2352 by 1568 pixels:
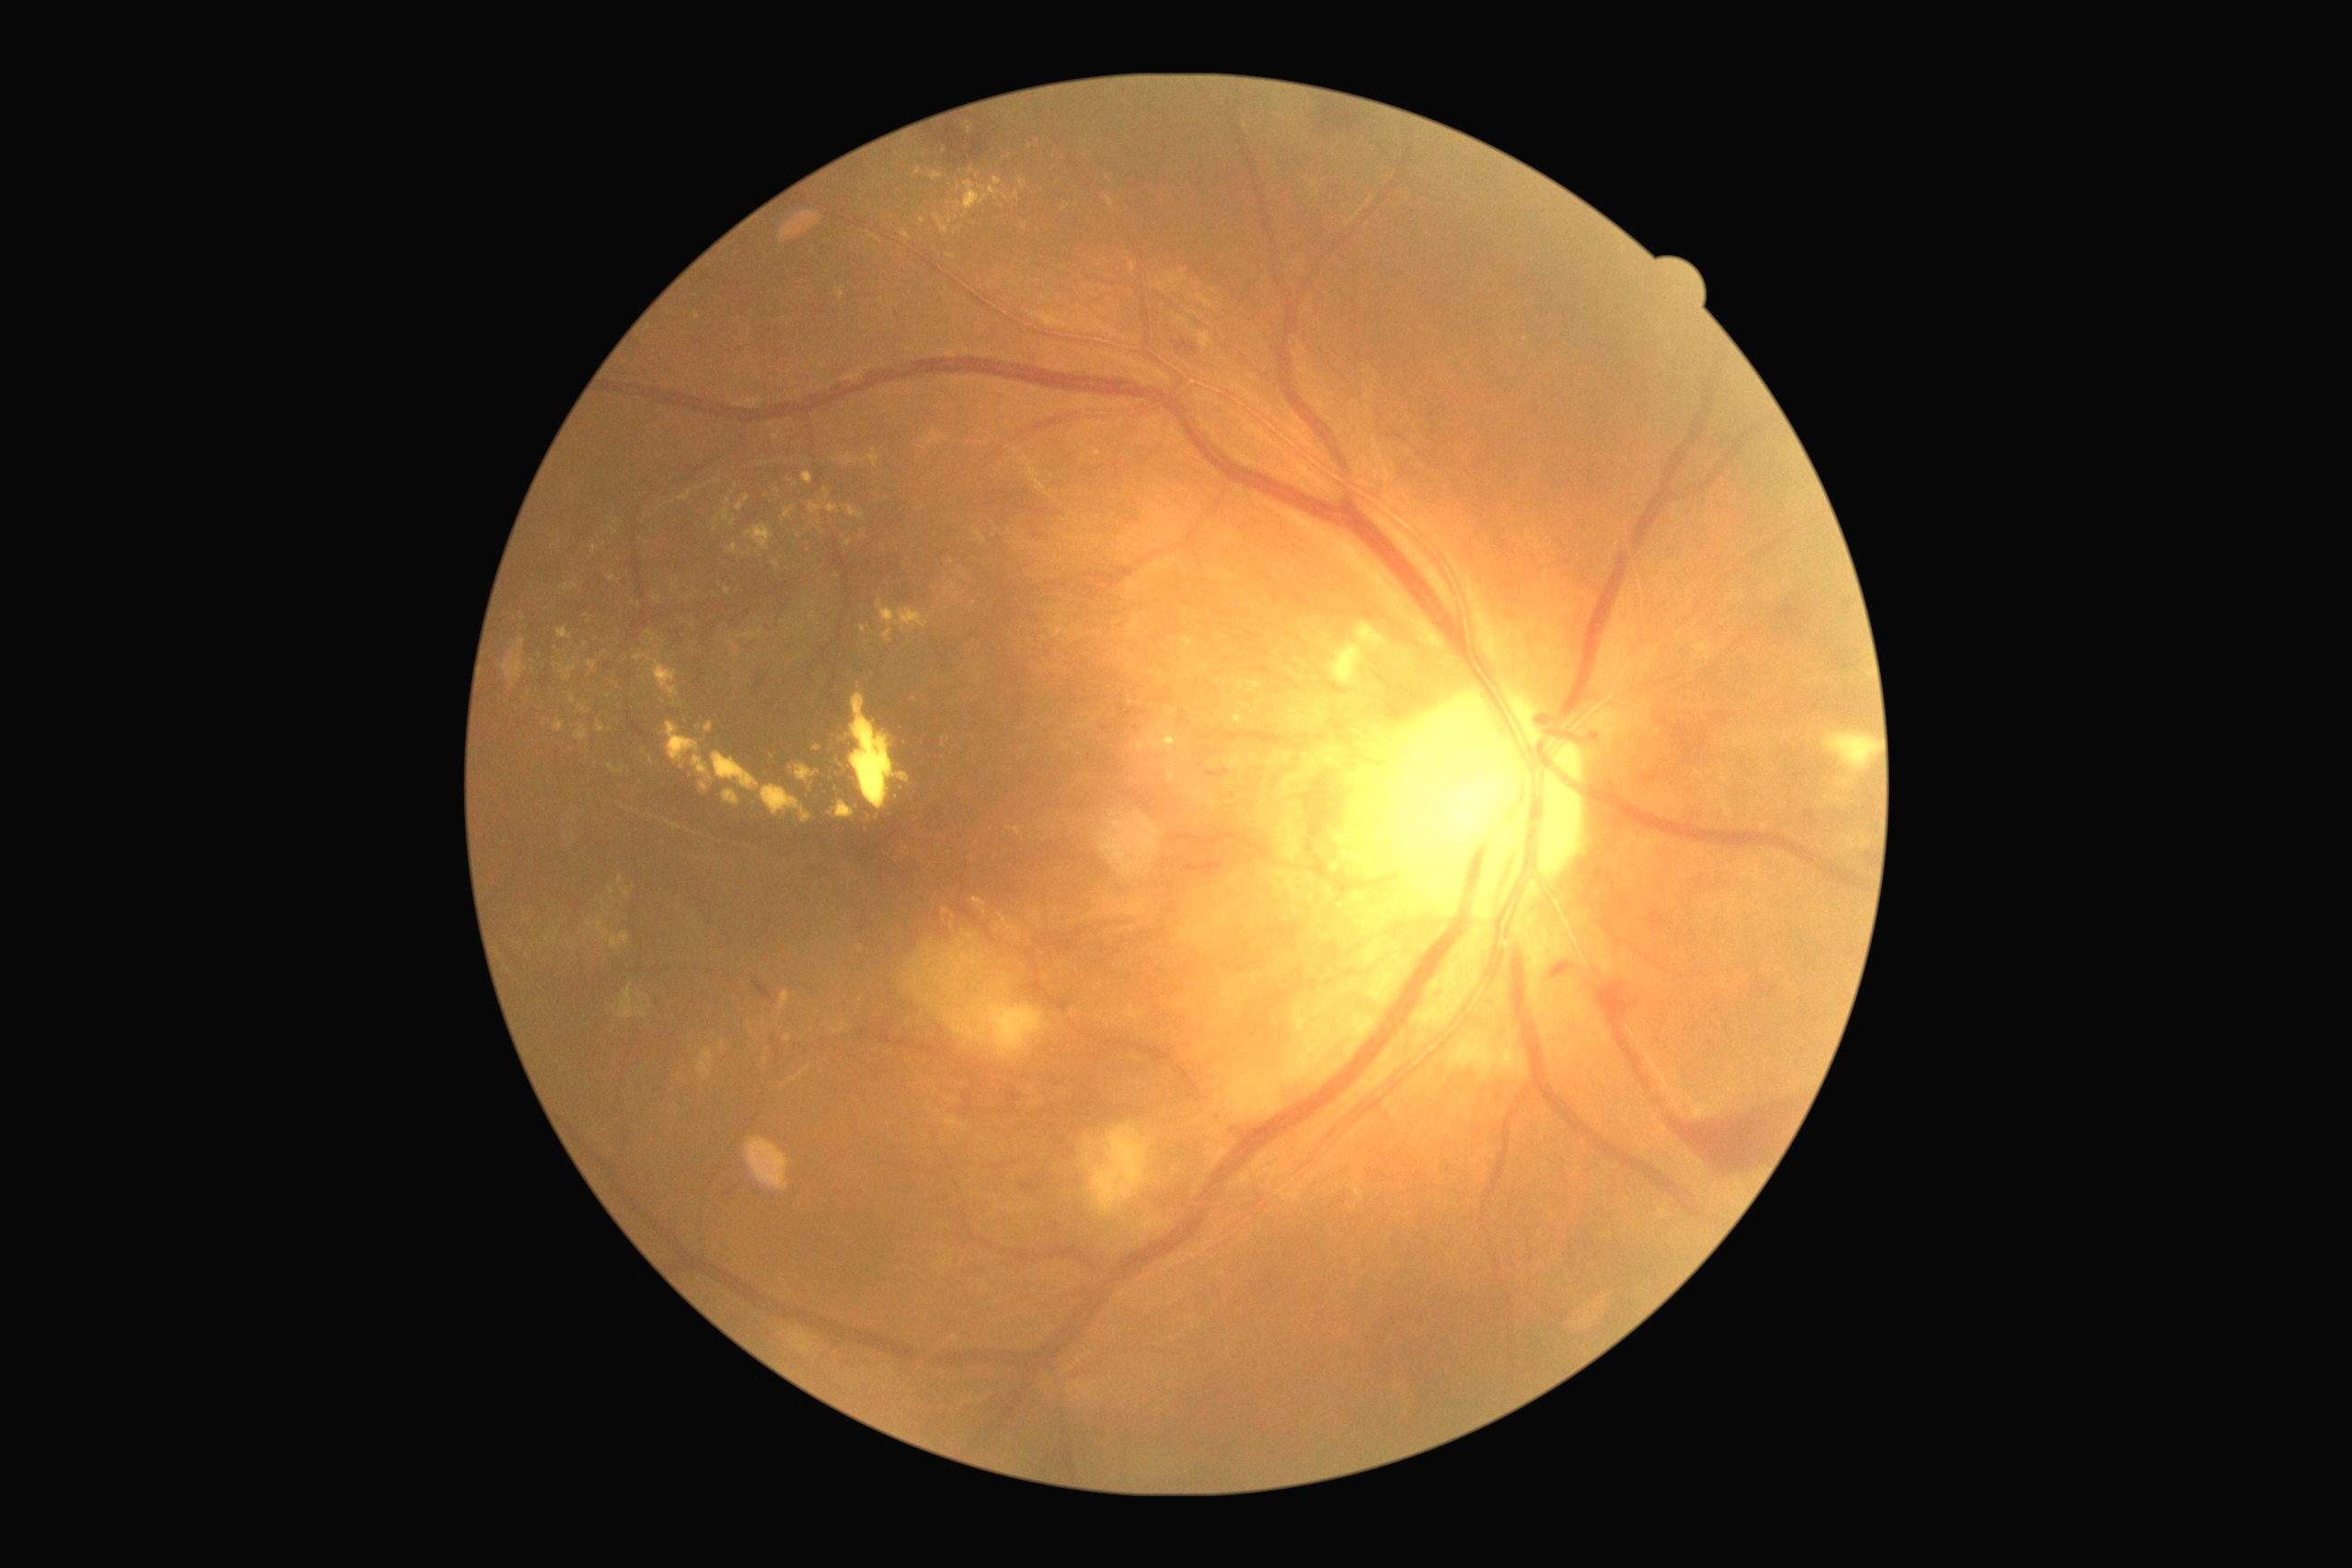
Diabetic retinopathy (DR) is 4 — neovascularization and/or vitreous/pre-retinal hemorrhage
A subset of detected lesions:
hard exudates (EXs) (more not shown) = [558,627,573,640] | [1233,716,1246,725] | [761,785,812,825] | [725,587,732,596] | [870,235,881,242] | [560,583,578,593] | [808,504,839,514] | [736,495,750,513] | [1166,707,1177,716] | [607,765,622,774] | [587,916,611,939]
EXs (small, approximate centers) near [848,543] | [1130,703] | [909,1022] | [663,701] | [978,176] | [698,316] | [555,665]